Camera: Remidio Fundus on Phone (FOP) camera, image size 1659x2212: 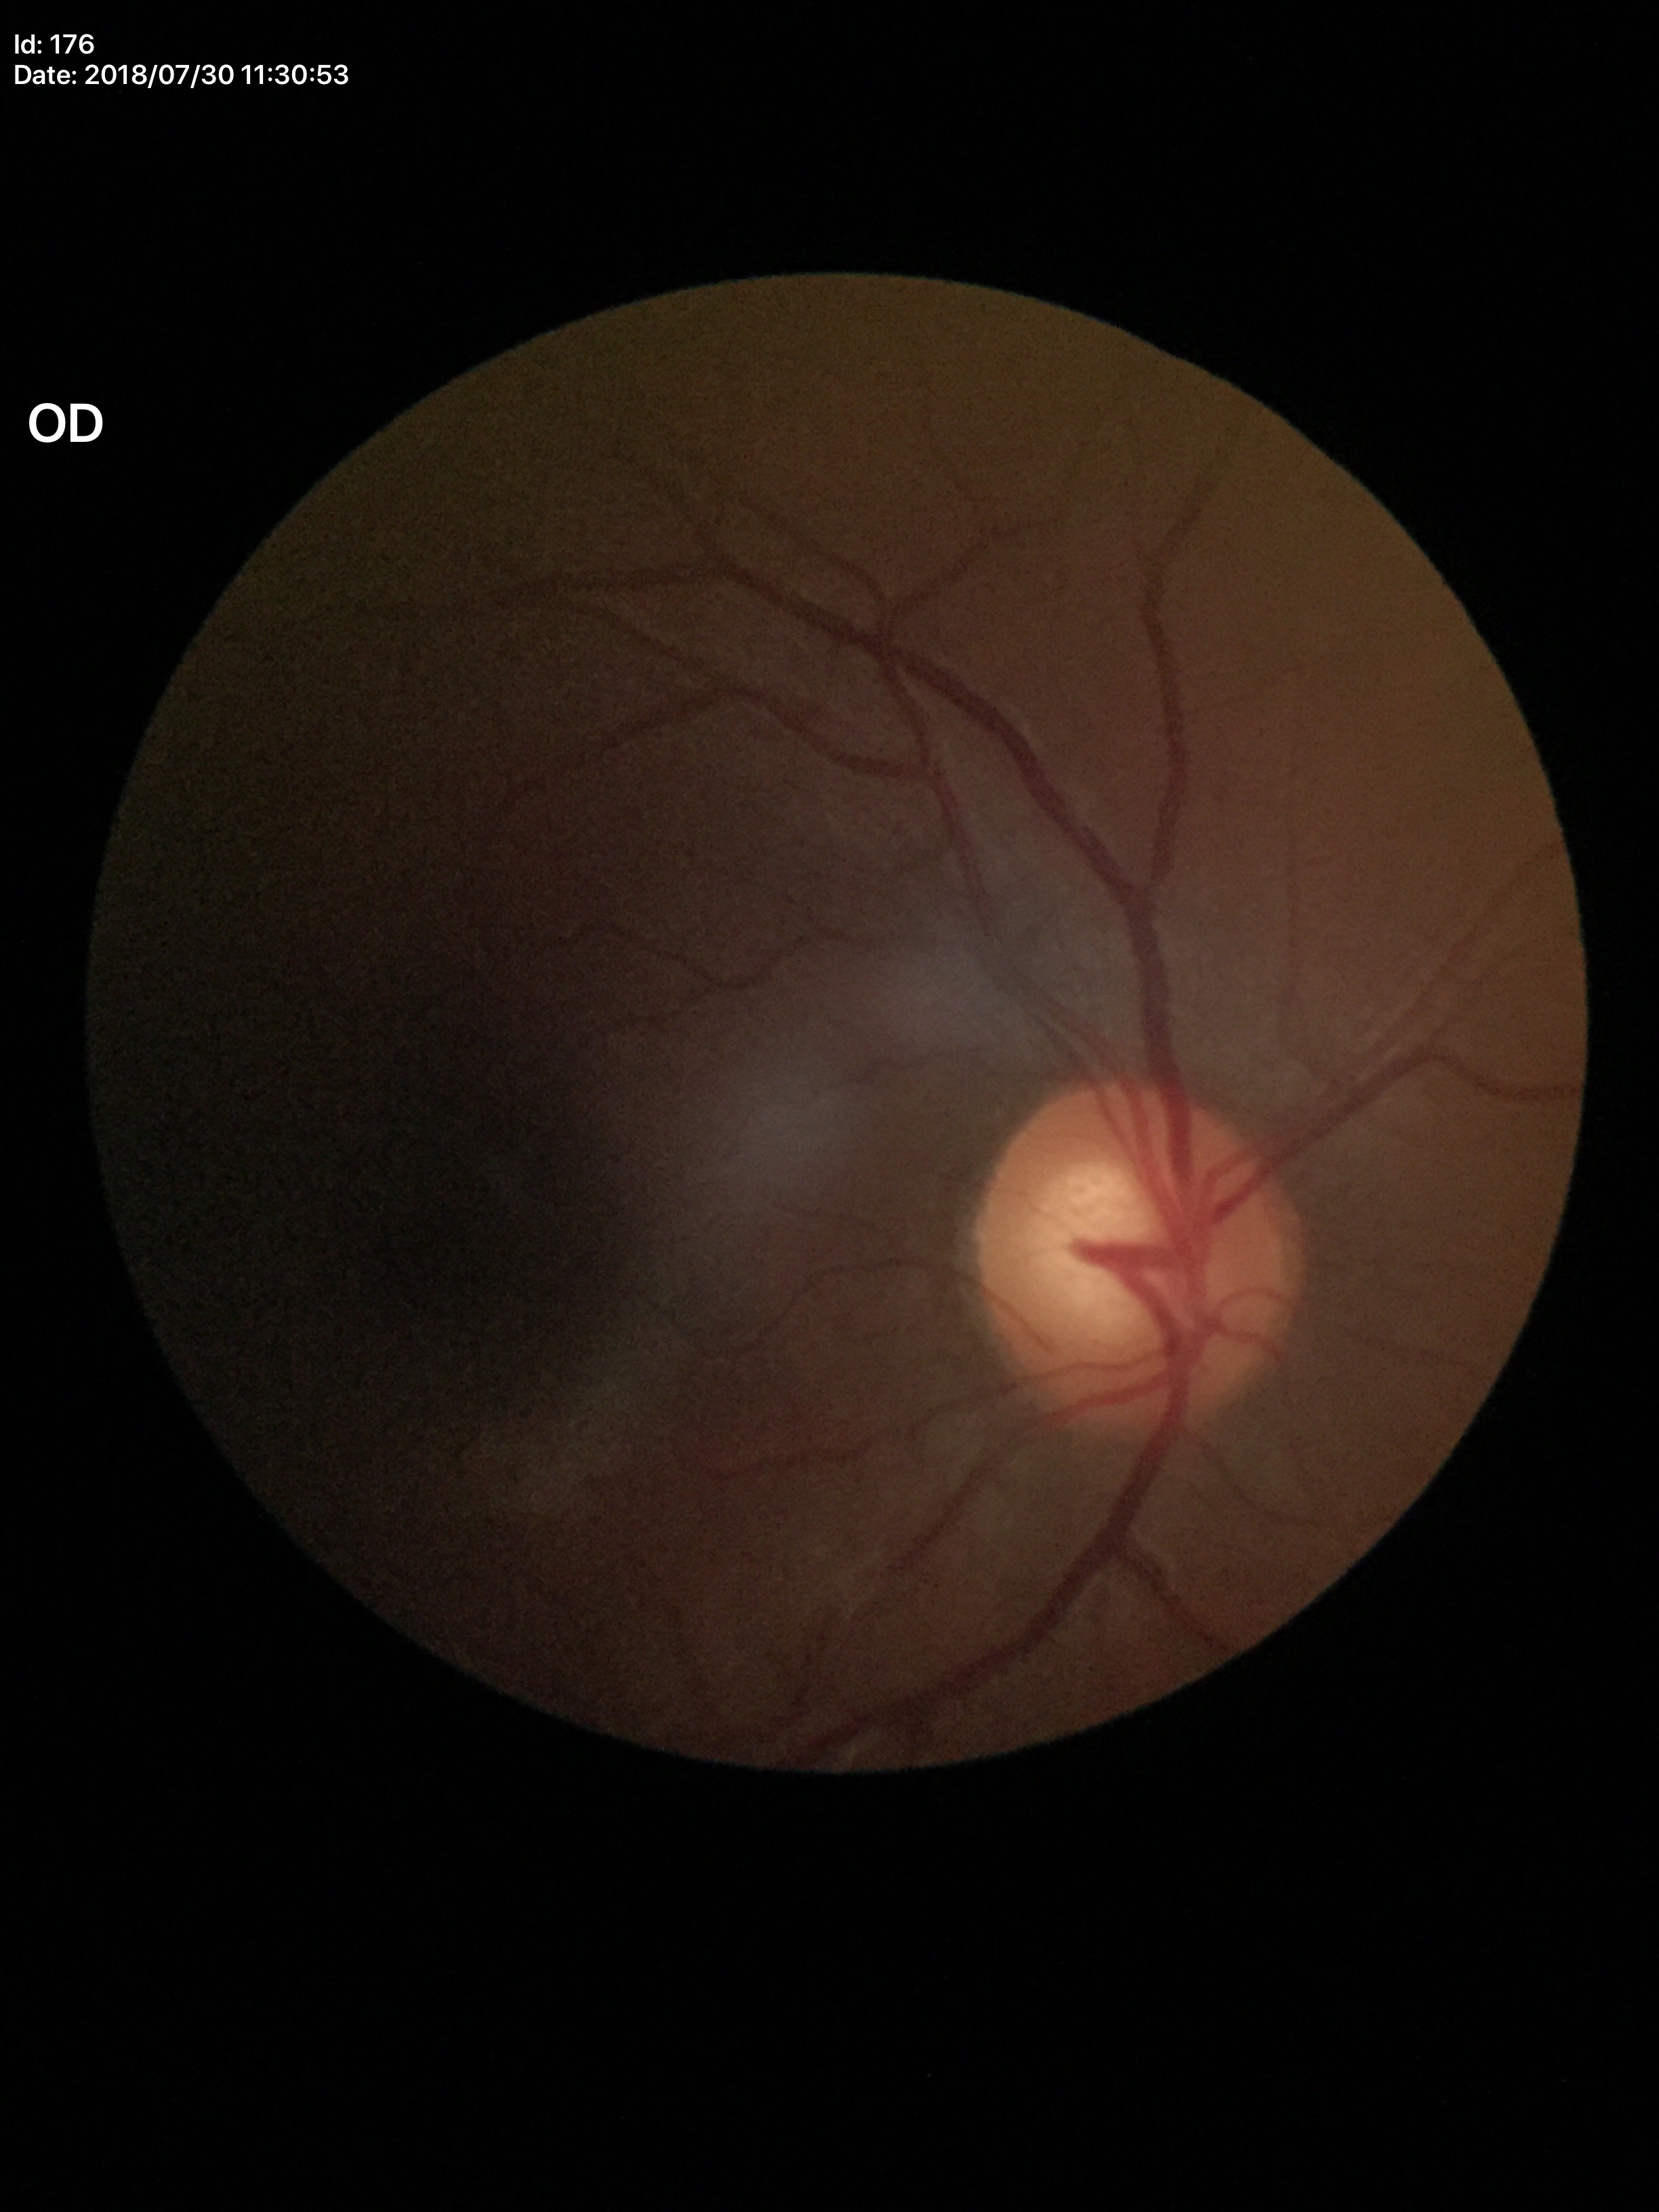 vertical cup-to-disc ratio: 0.59; Glaucoma screening: suspicious